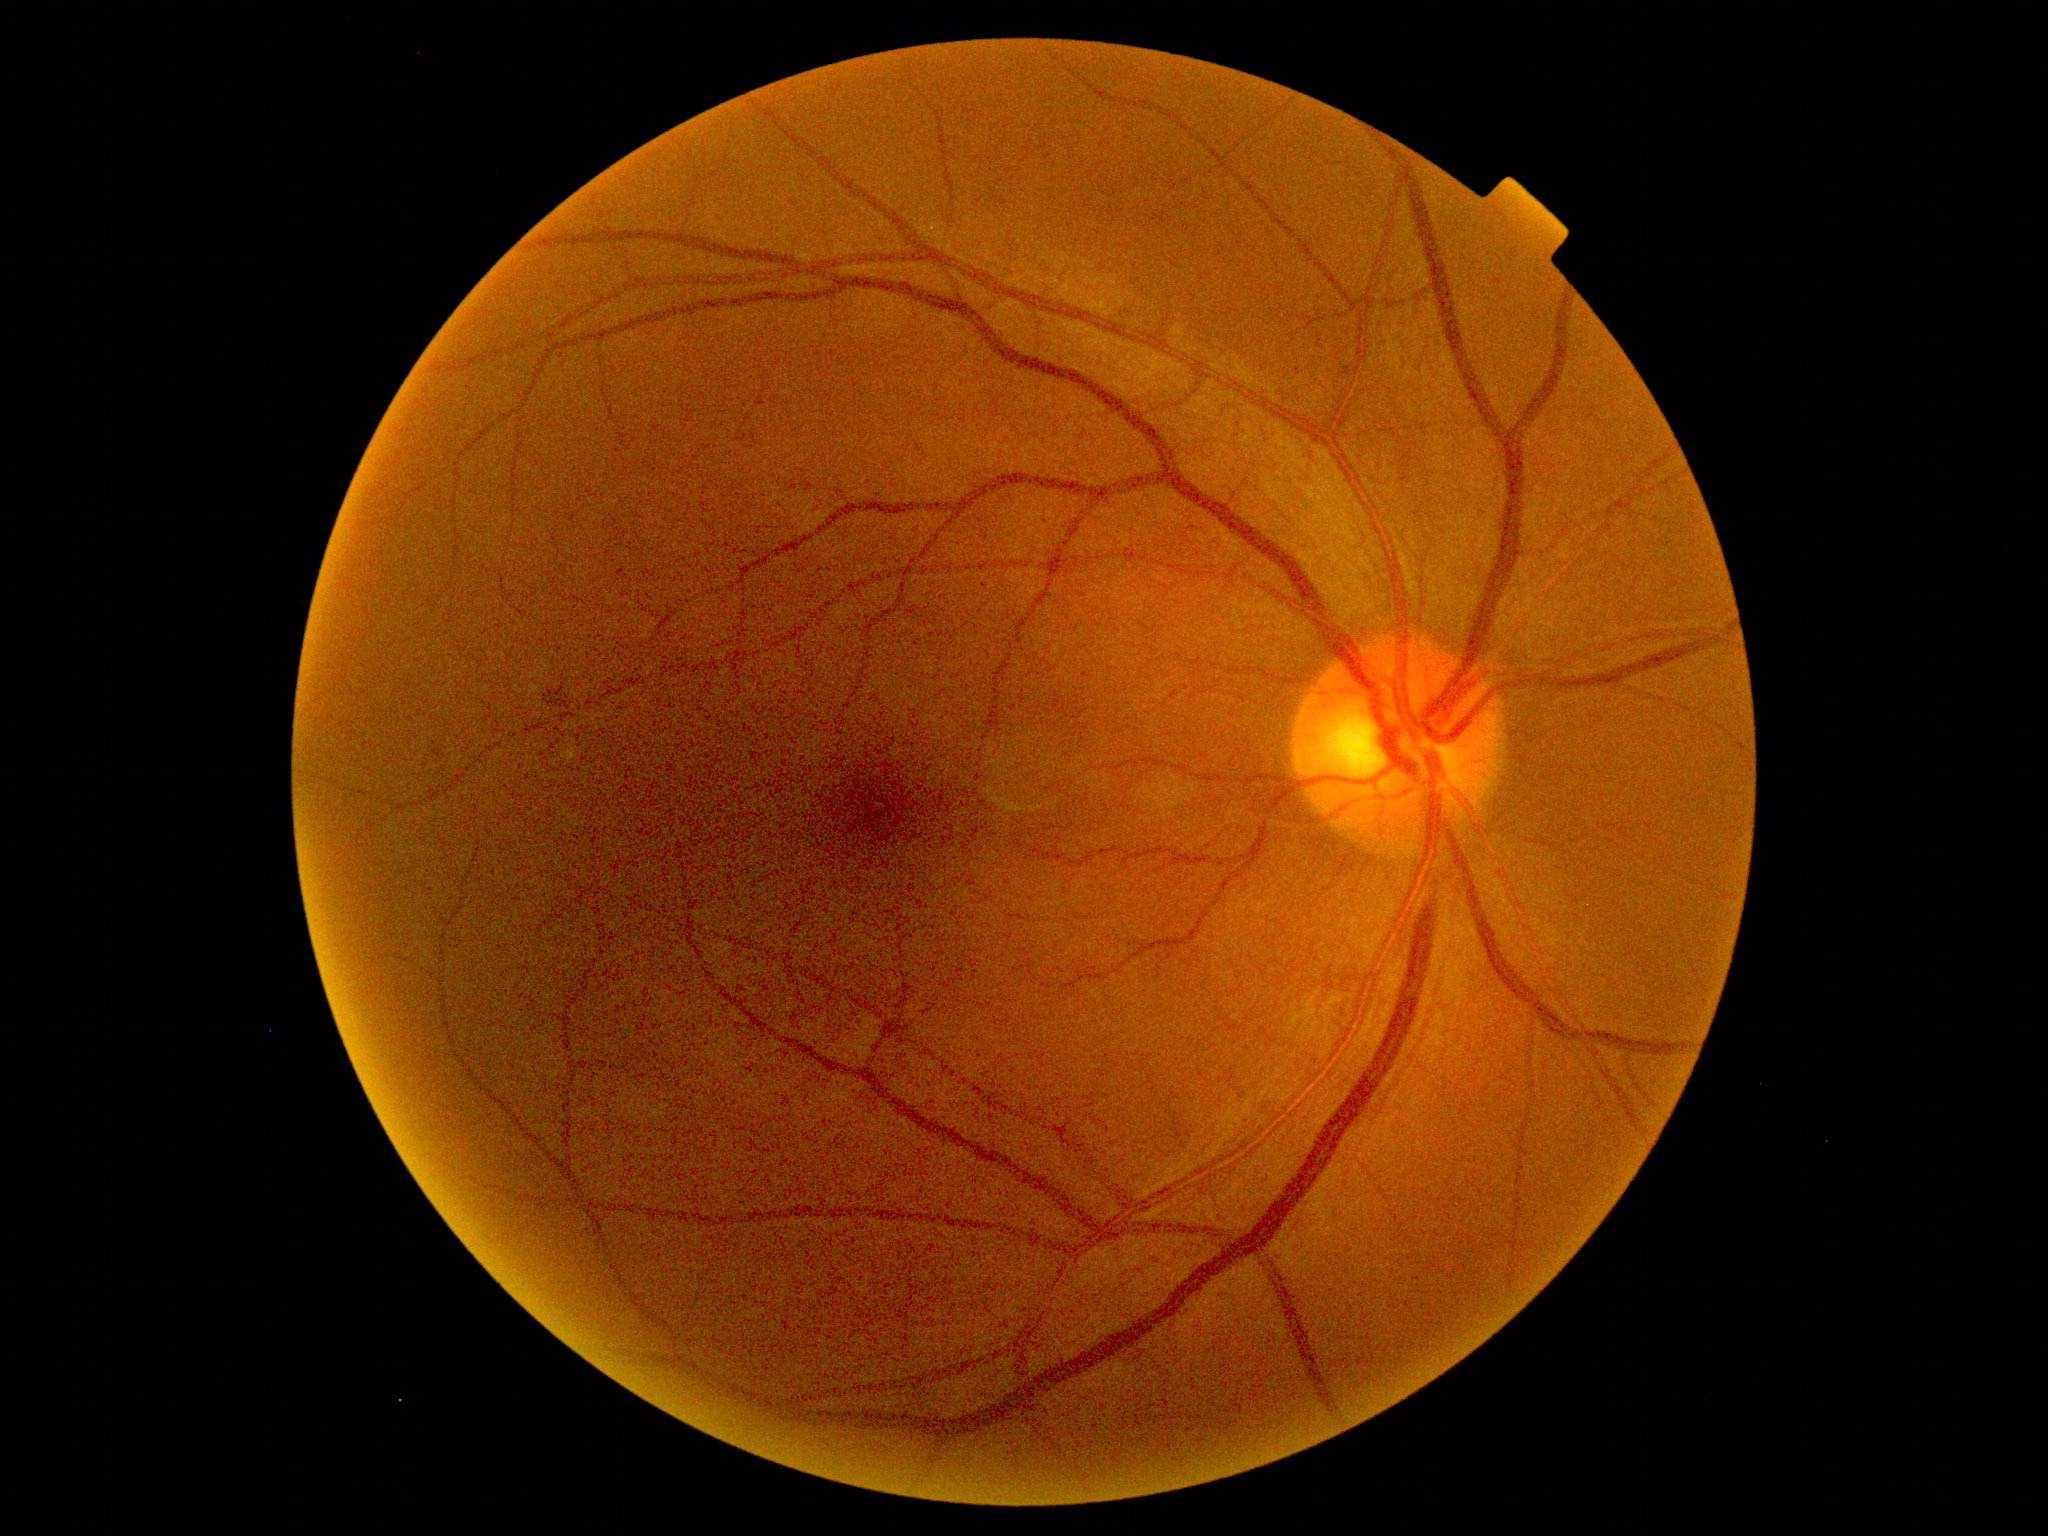
Findings:
• diabetic retinopathy: grade 2 (moderate NPDR) — more than just microaneurysms but less than severe NPDR